Optic disc region of a color fundus photo; FOV 35° before cropping: 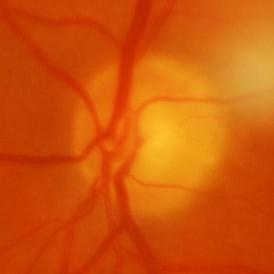

Impression = glaucoma.